DR severity per modified Davis staging. Nonmydriatic.
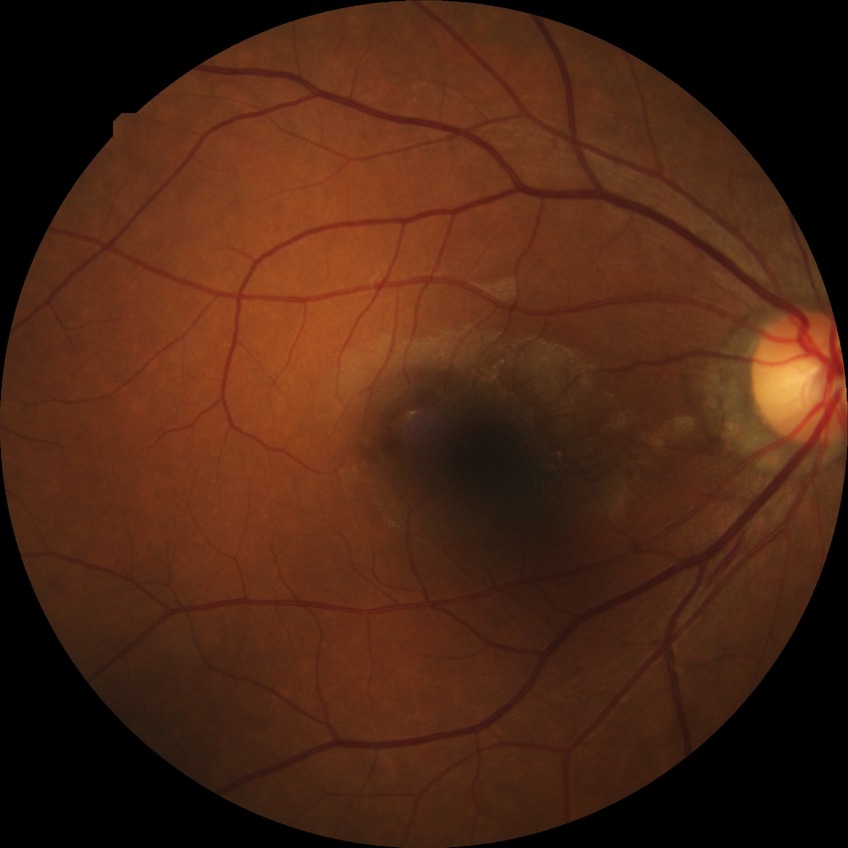 Diabetic retinopathy severity is no diabetic retinopathy.